2212 by 1659 pixels; fundus photo
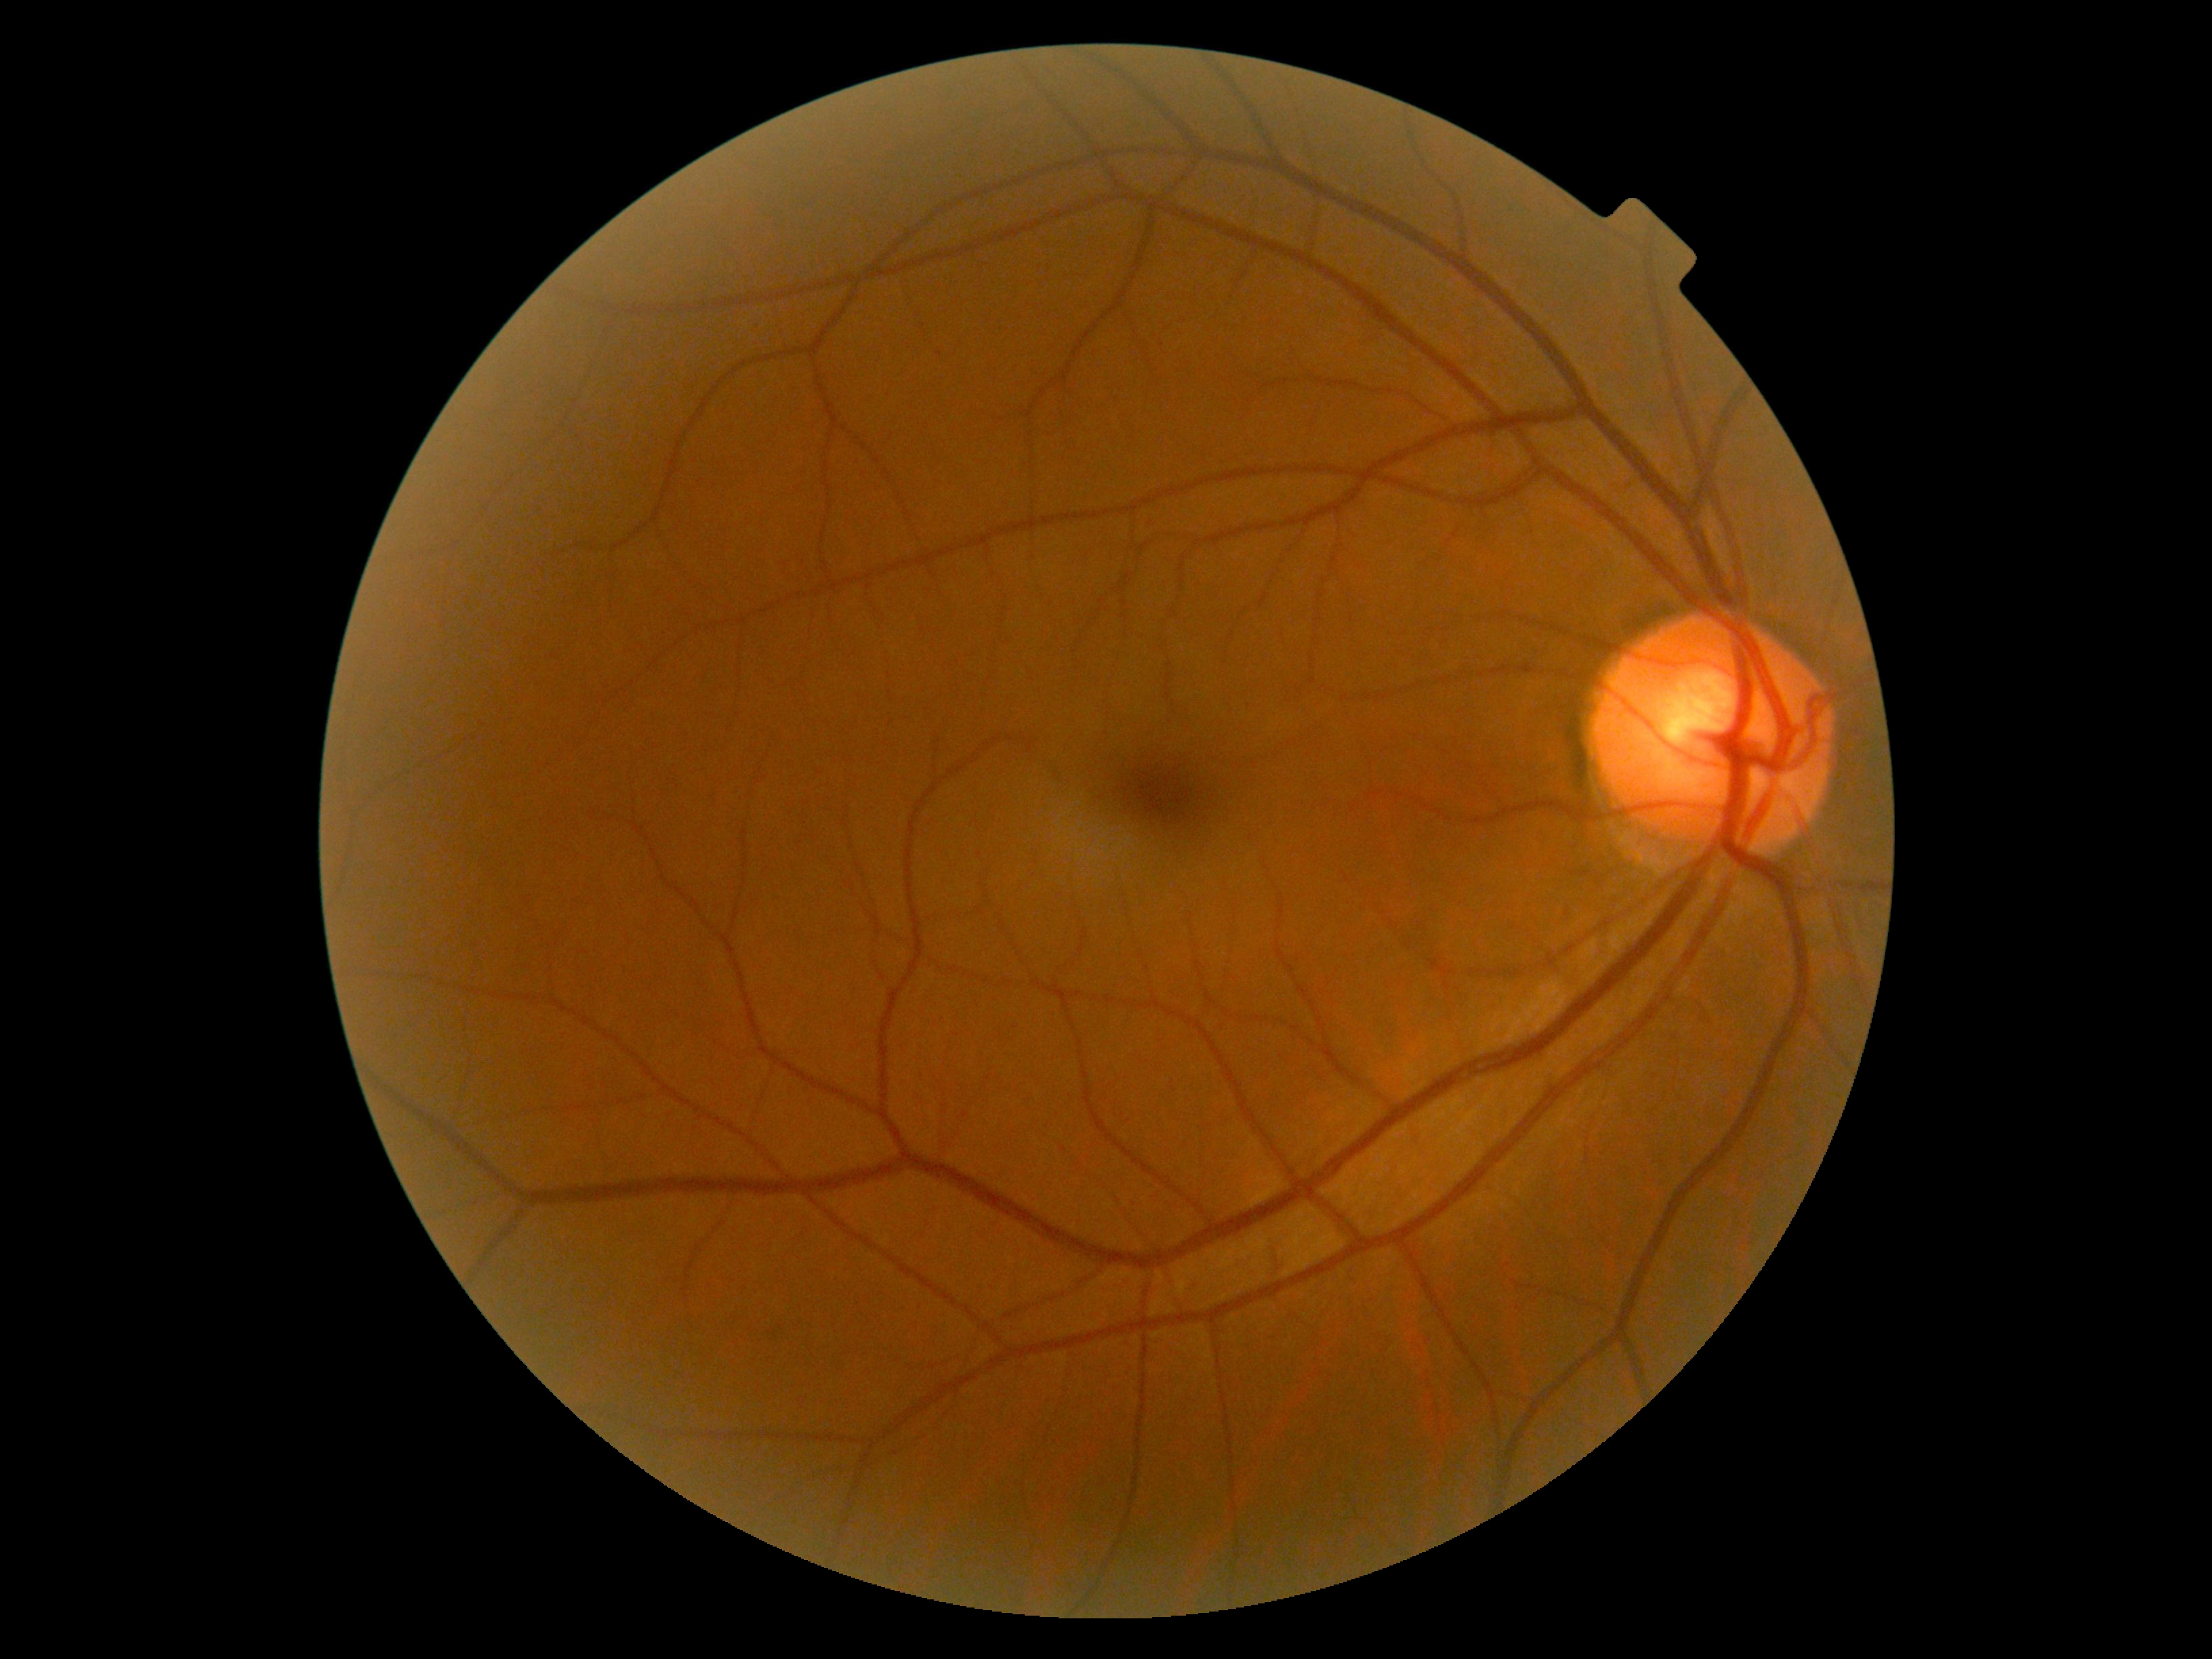

DR is 0 — no visible signs of diabetic retinopathy.